Portable fundus camera image:
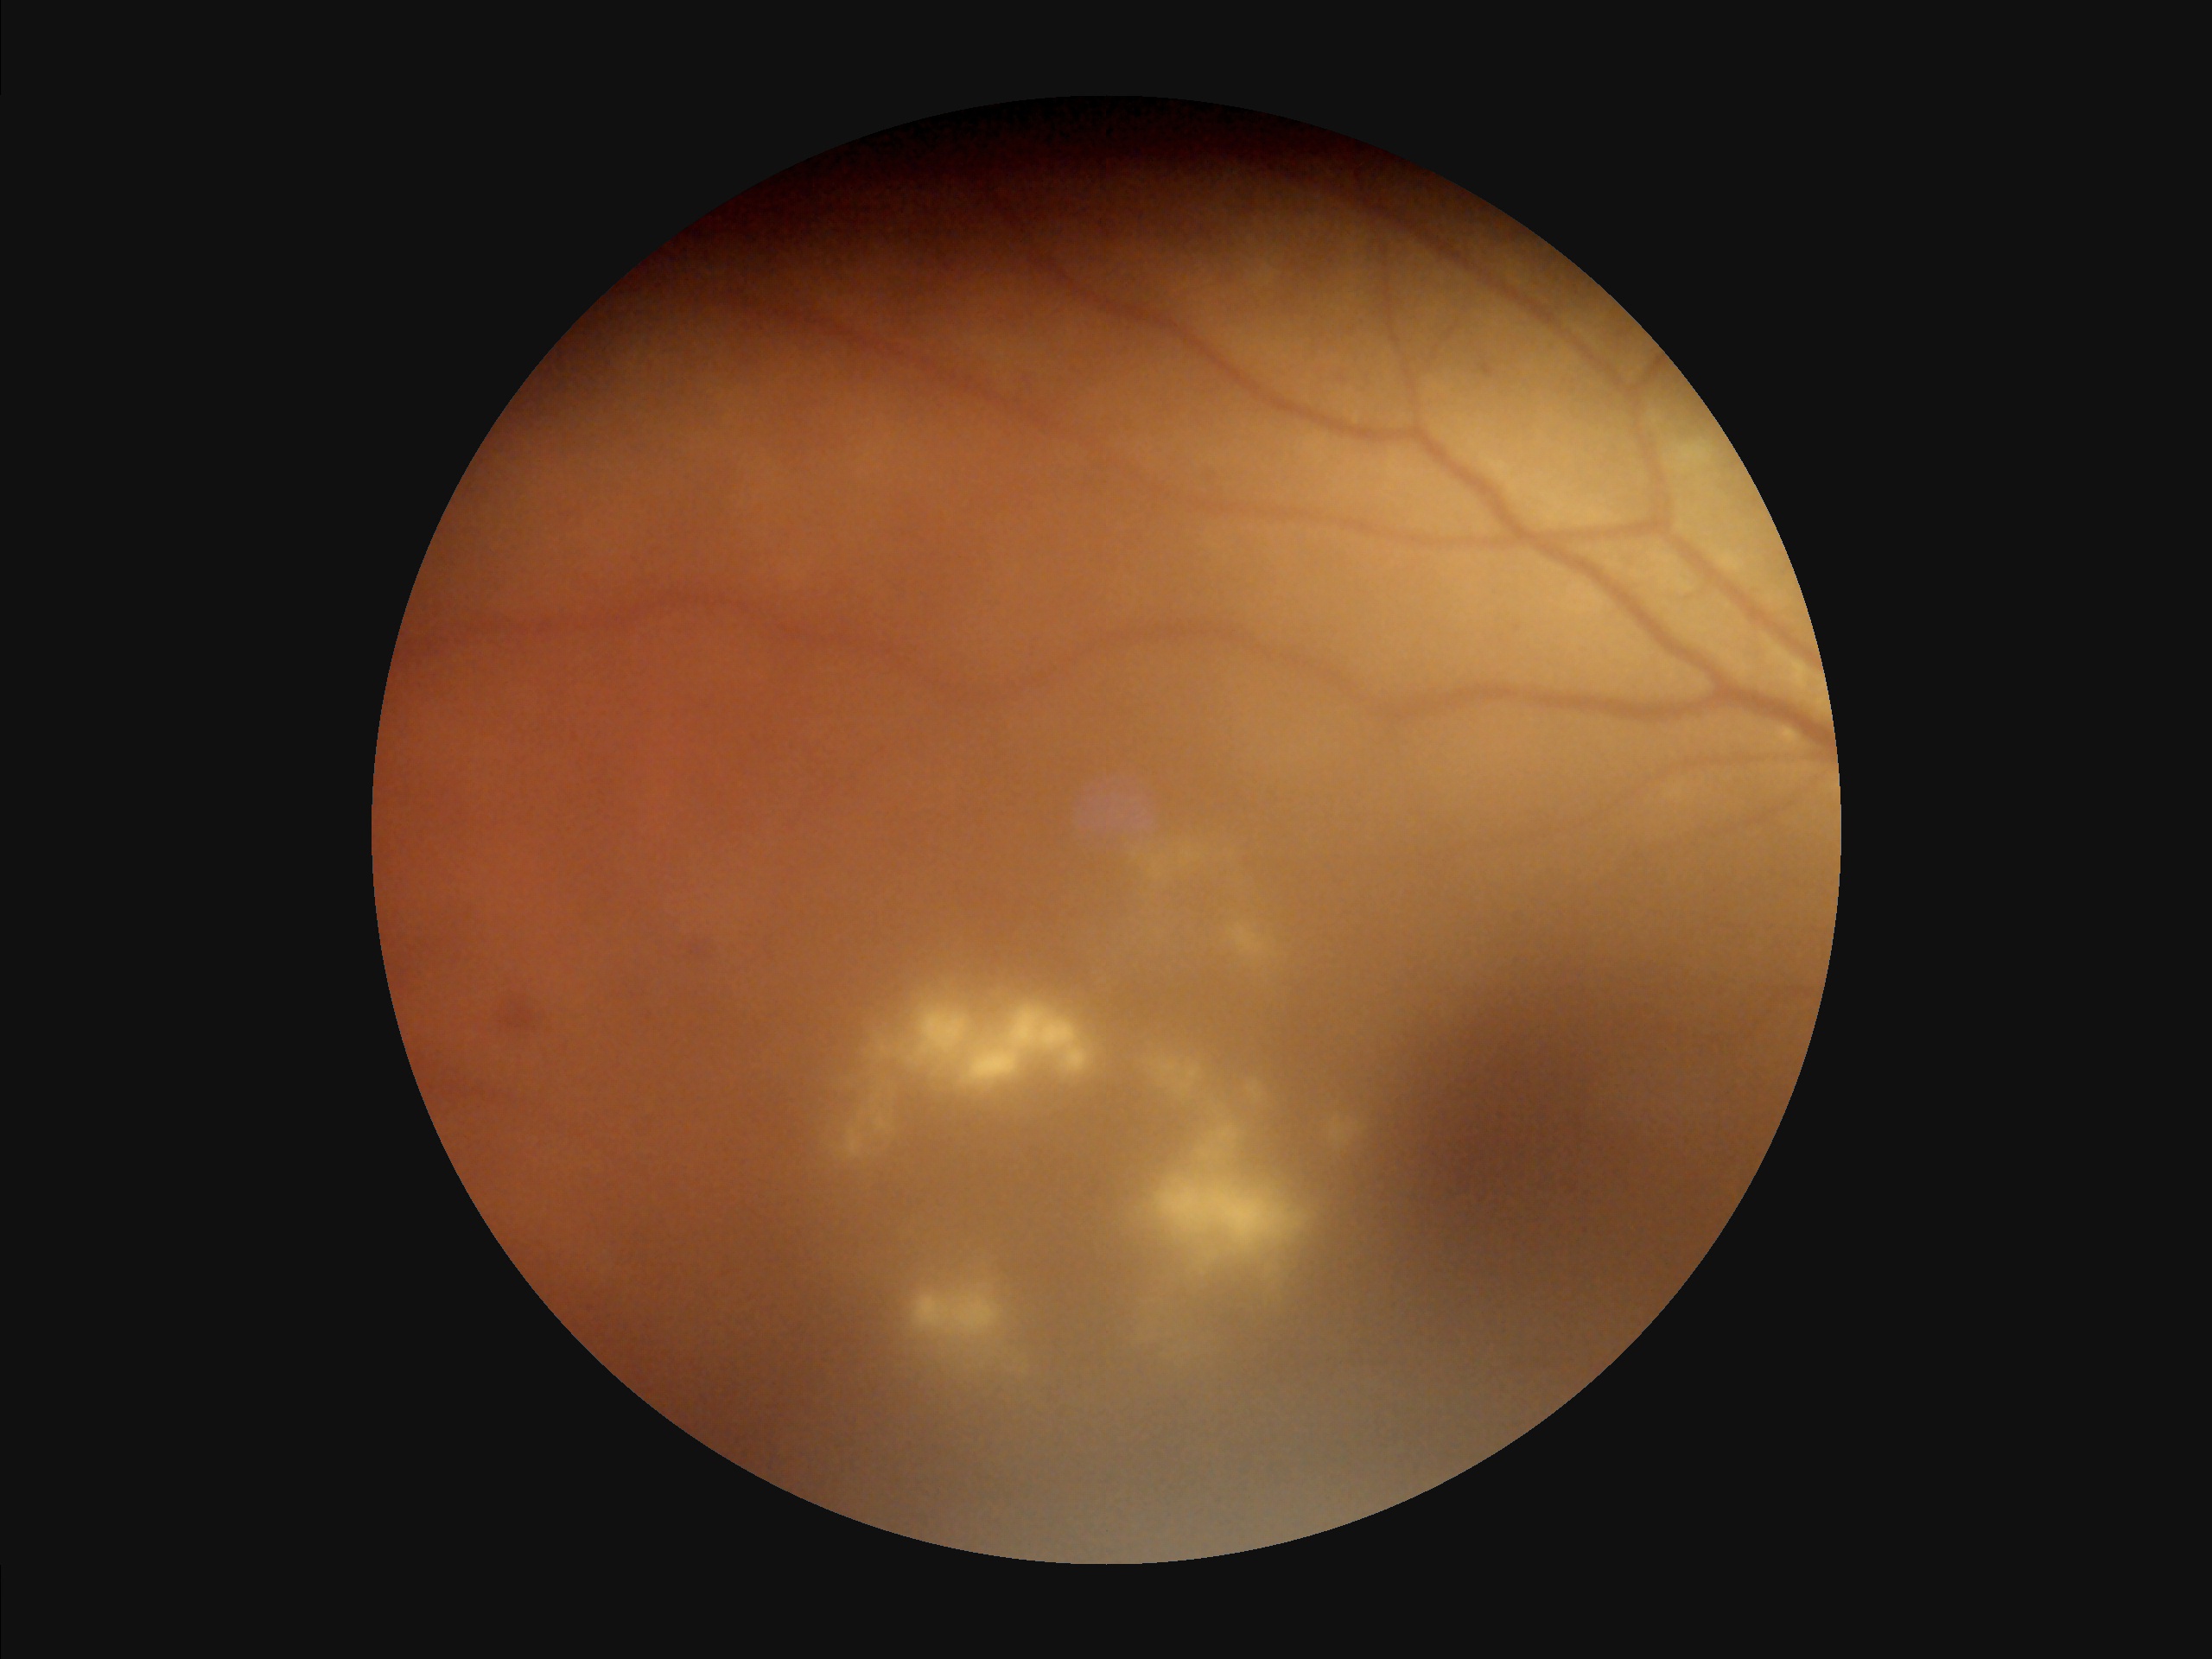

Image quality is inadequate for diagnostic use. Reduced sharpness with visible blur. Contrast is low. Even illumination with no color cast.